No pharmacologic dilation — 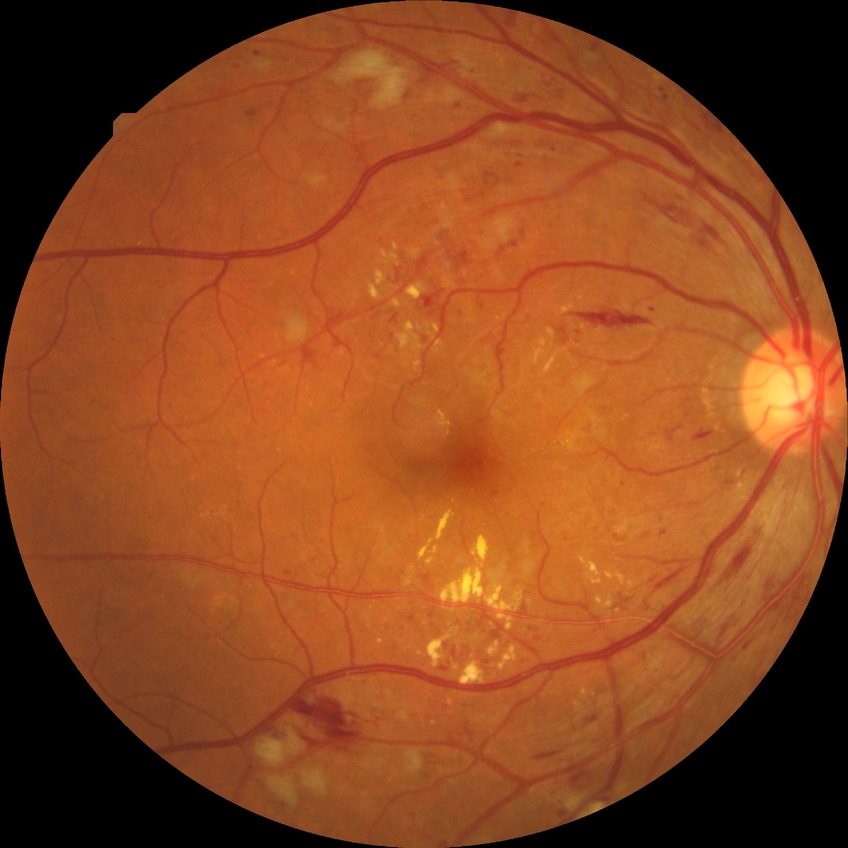

{
  "davis_grade": "PPDR"
}